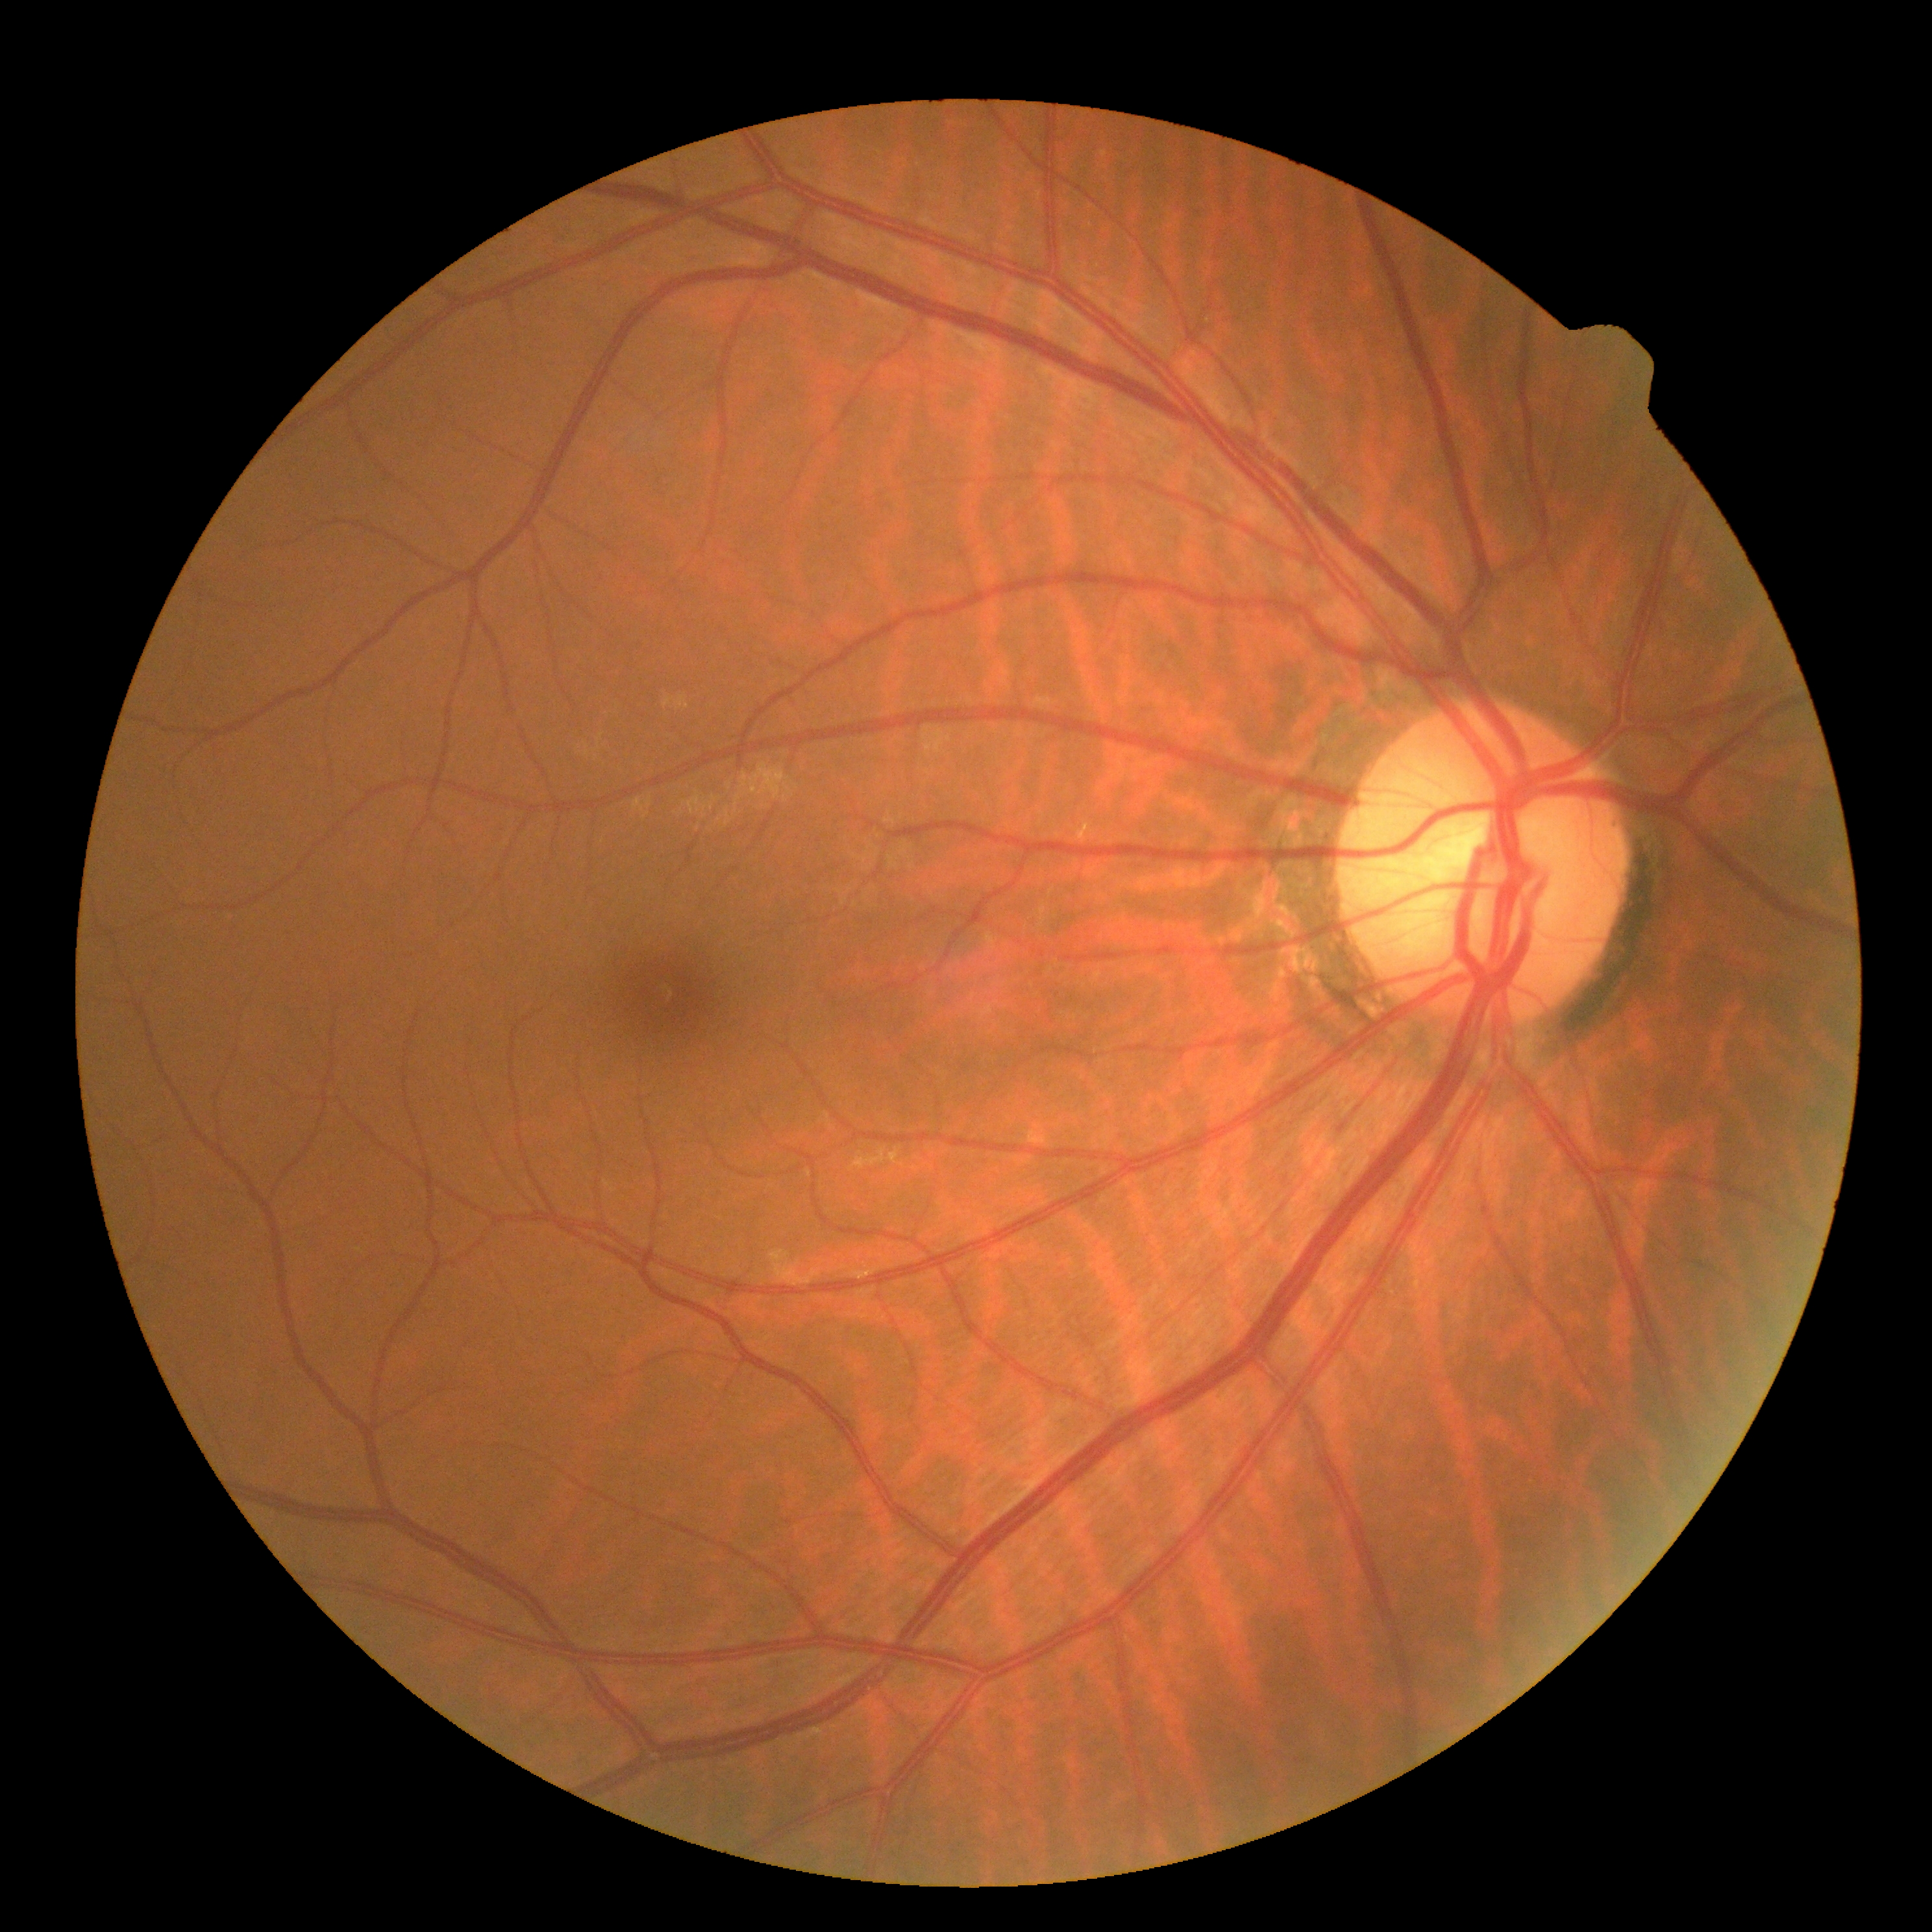

DR stage=grade 0 (no apparent retinopathy); DR impression=negative for DR.